45° FOV; 848 by 848 pixels:
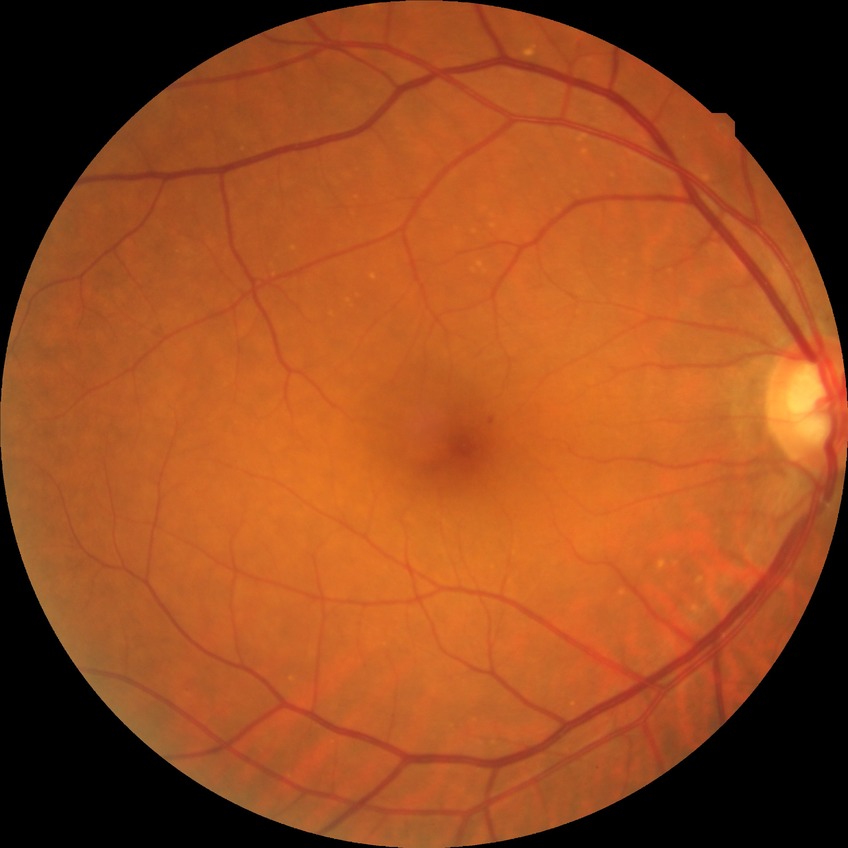

Davis stage: SDR.
The retinopathy is classified as non-proliferative diabetic retinopathy.